1240 x 1240 pixels; camera: Phoenix ICON (100° FOV); pediatric wide-field fundus photograph: 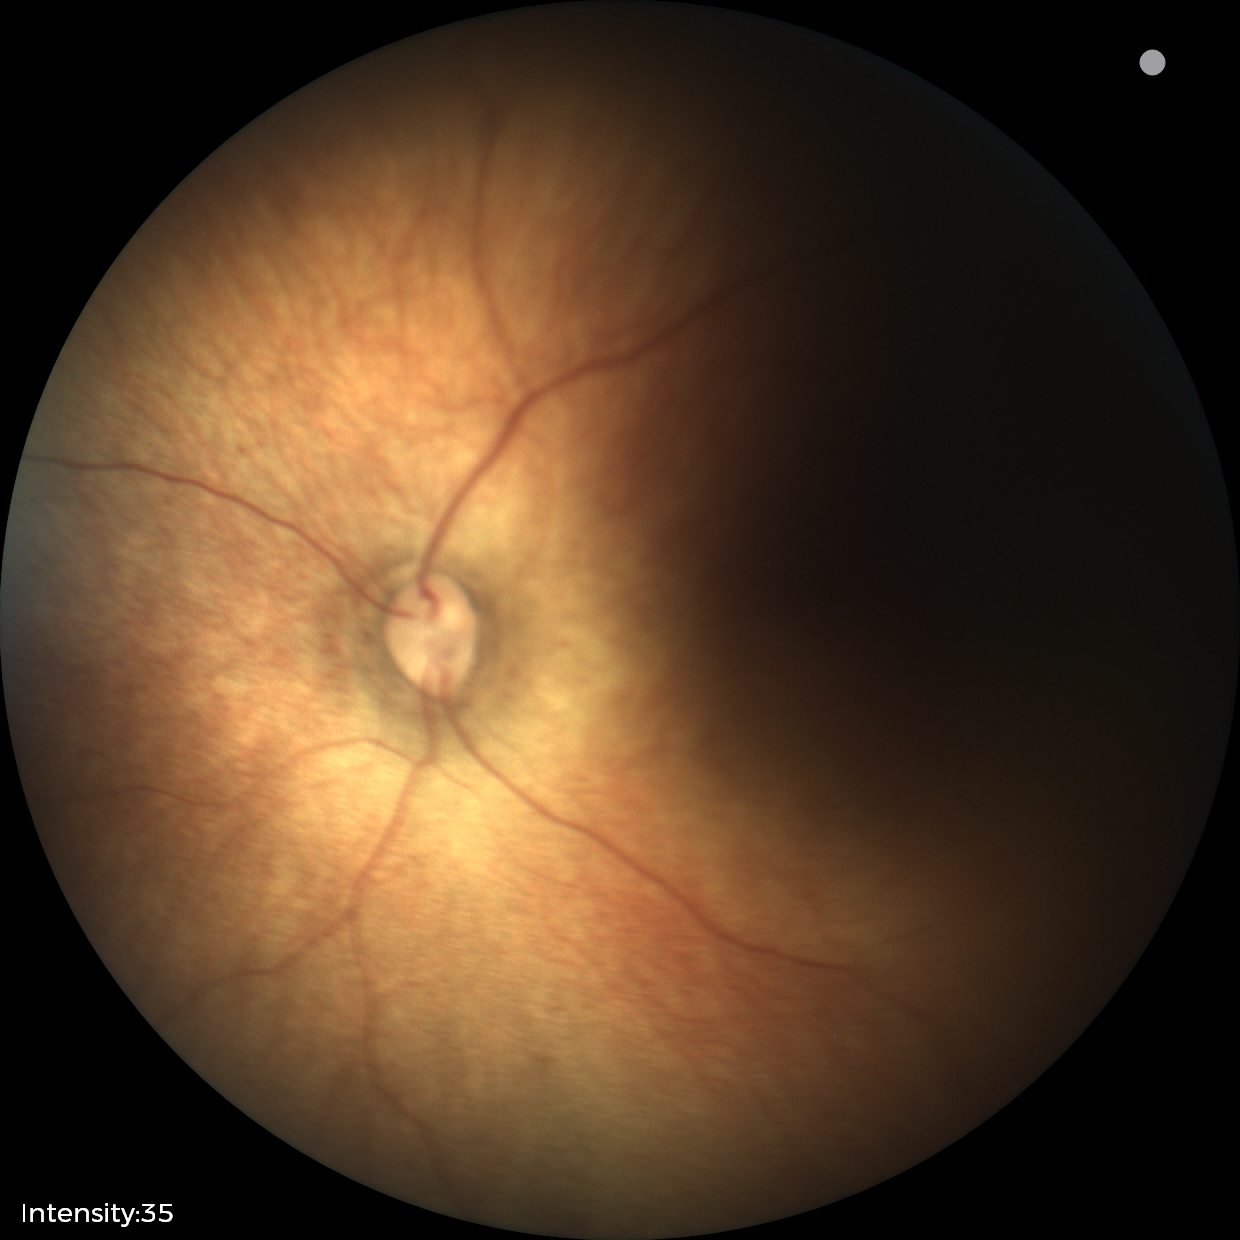 Examination with physiological retinal findings.